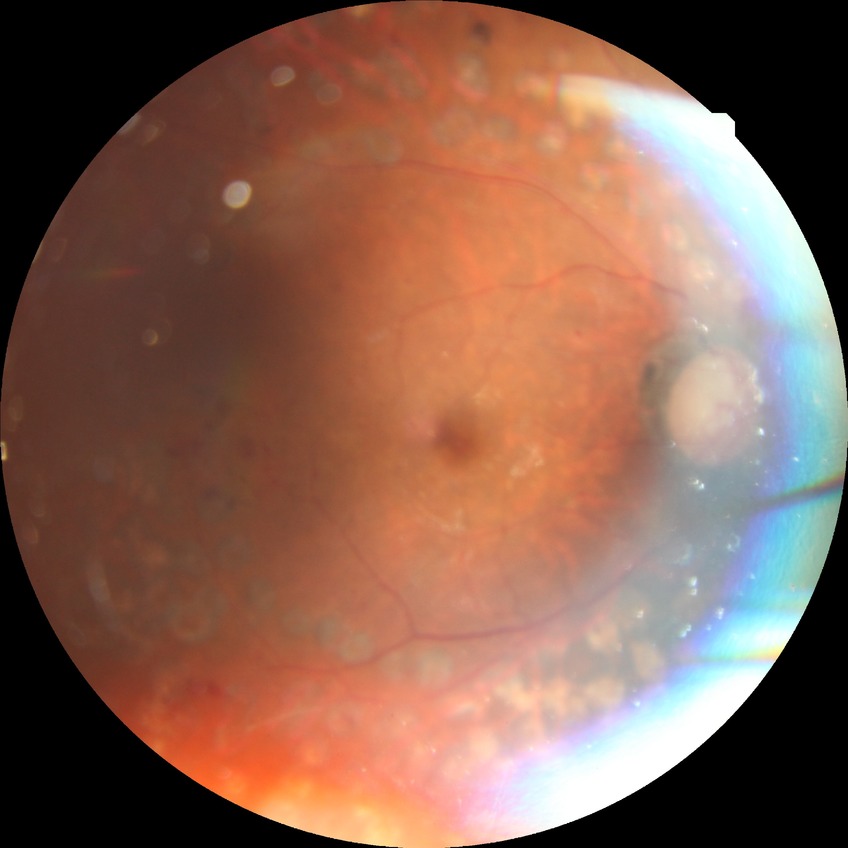
Diabetic retinopathy stage: proliferative diabetic retinopathy.